Ultra-widefield fundus photograph:
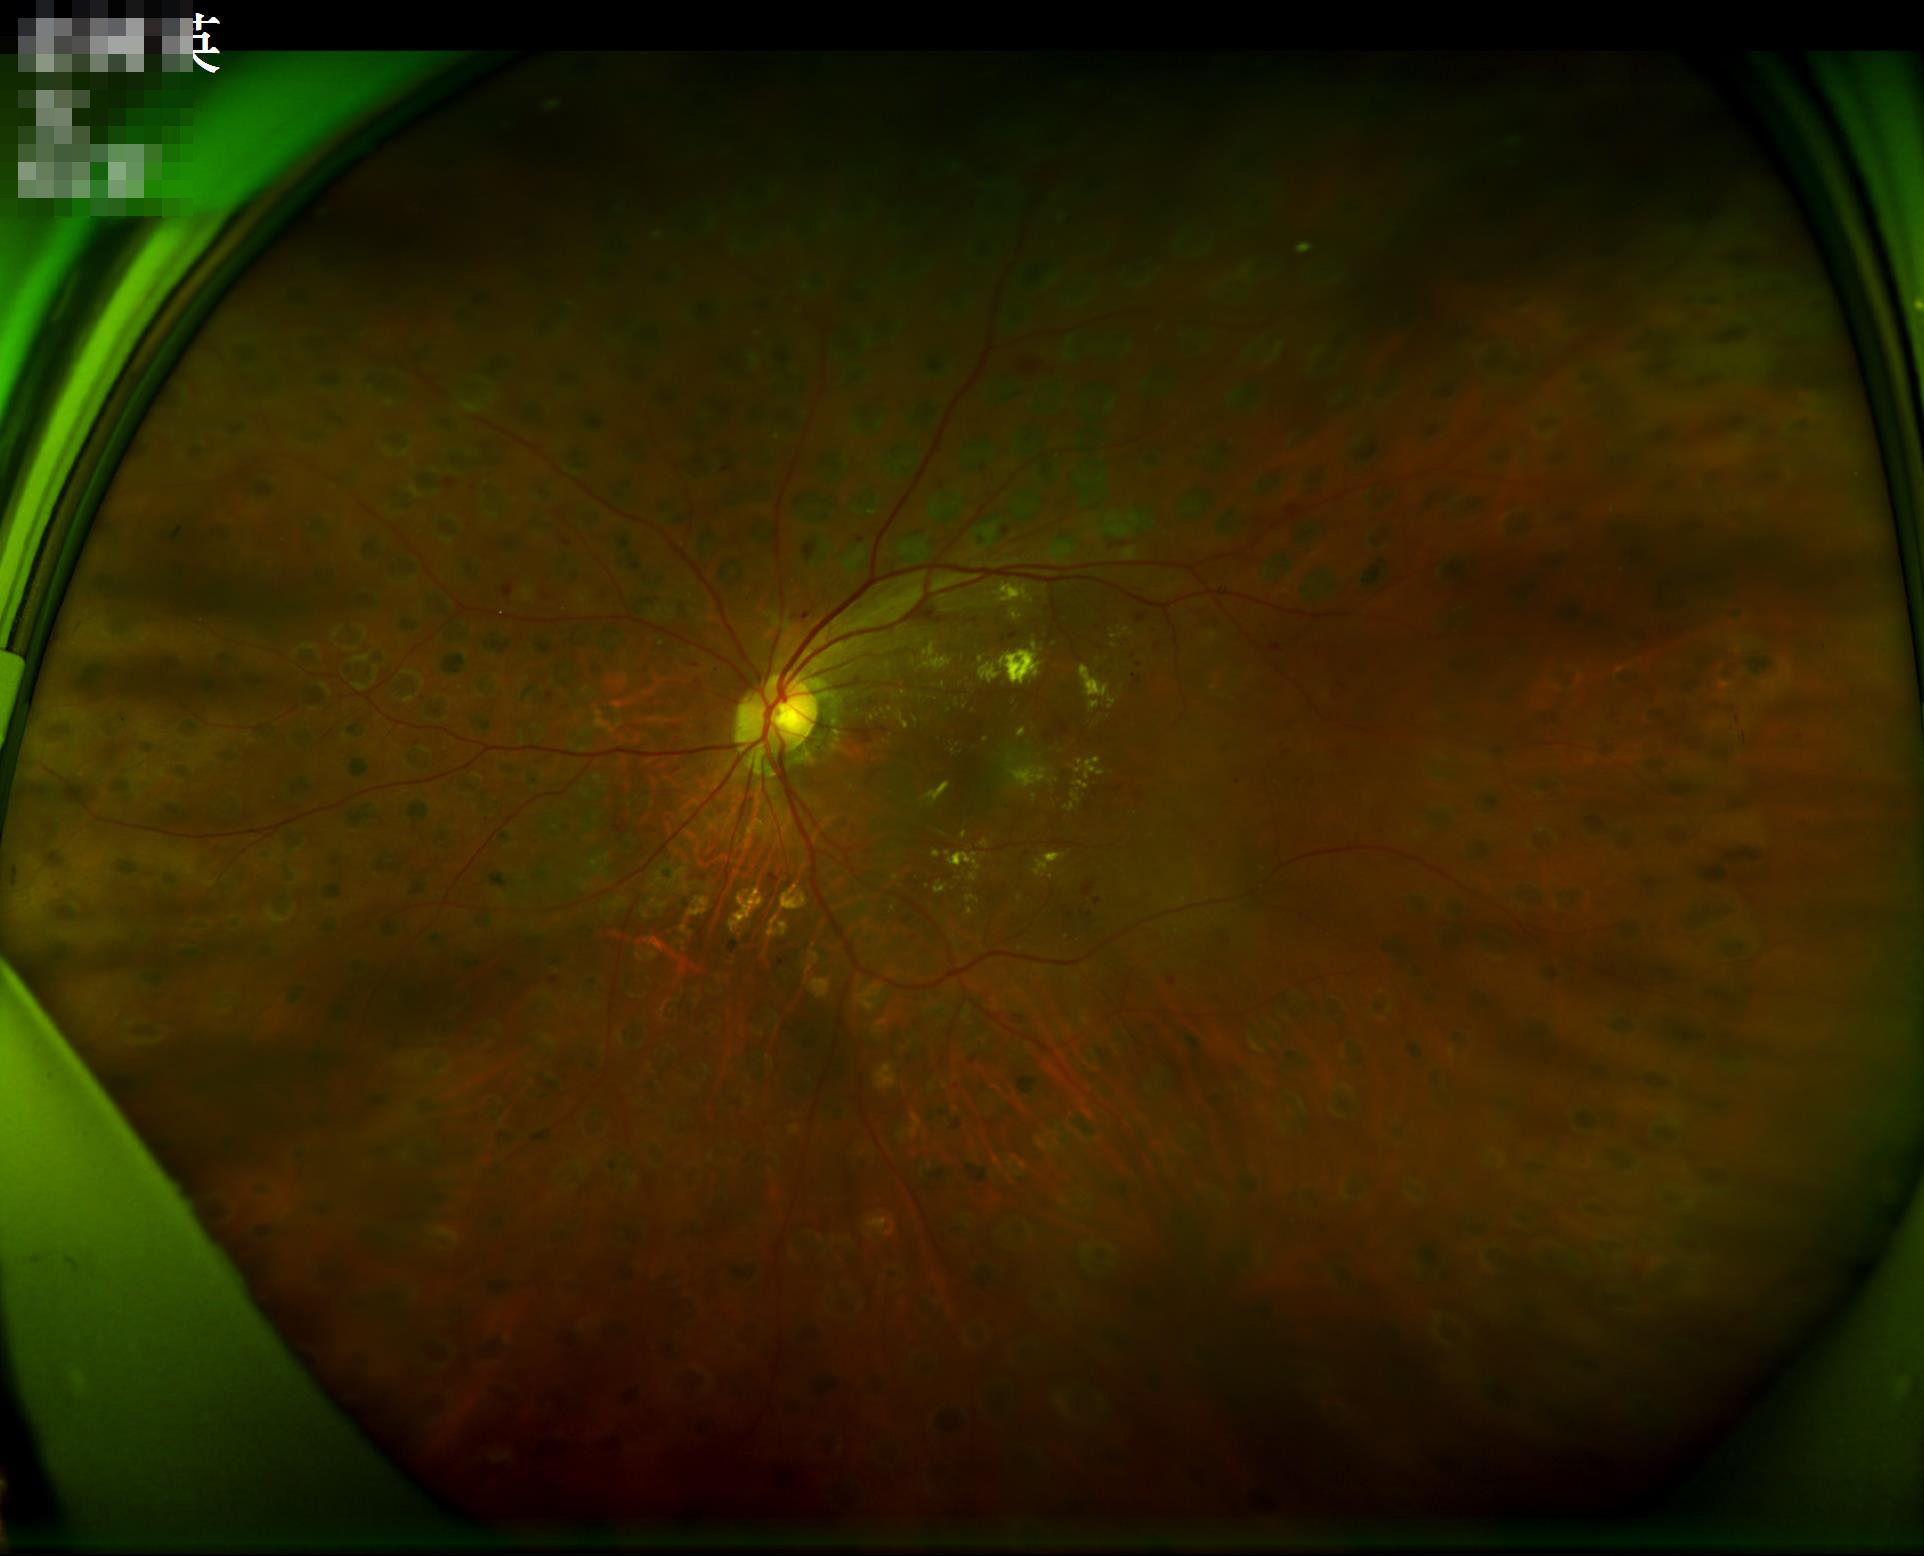

Illumination is uneven. Overall quality is good and the image is gradable. No noticeable blur. Adequate contrast for distinguishing structures.